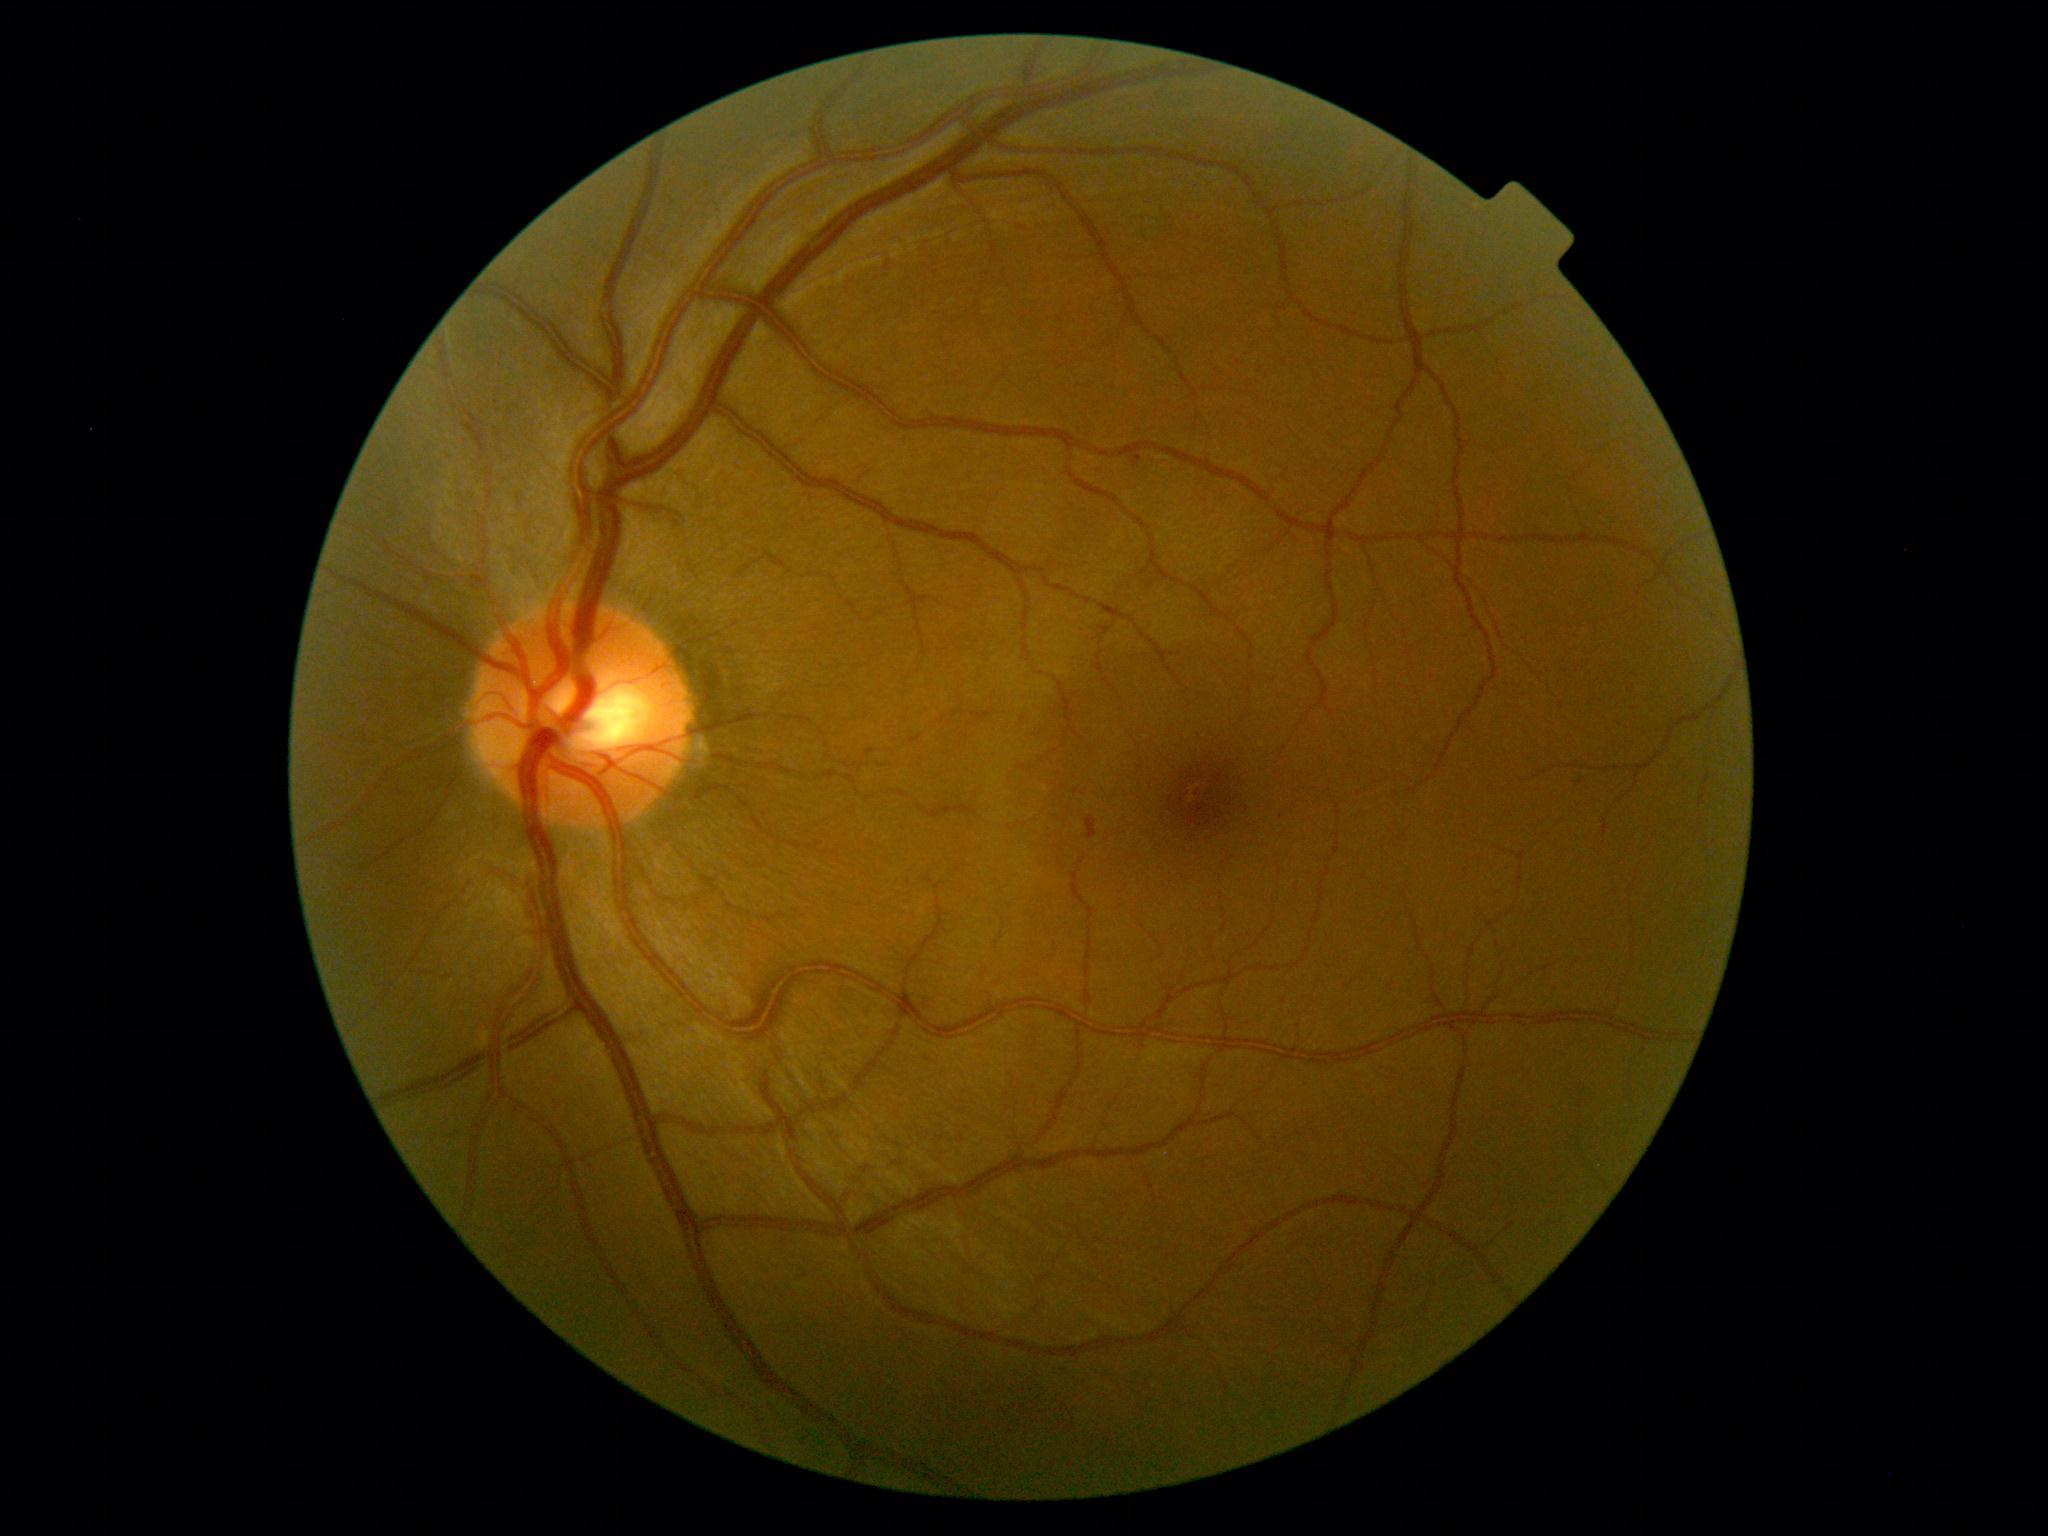   dr_grade: 2
  dr_category: non-proliferative diabetic retinopathy